2346 x 1568 pixels — 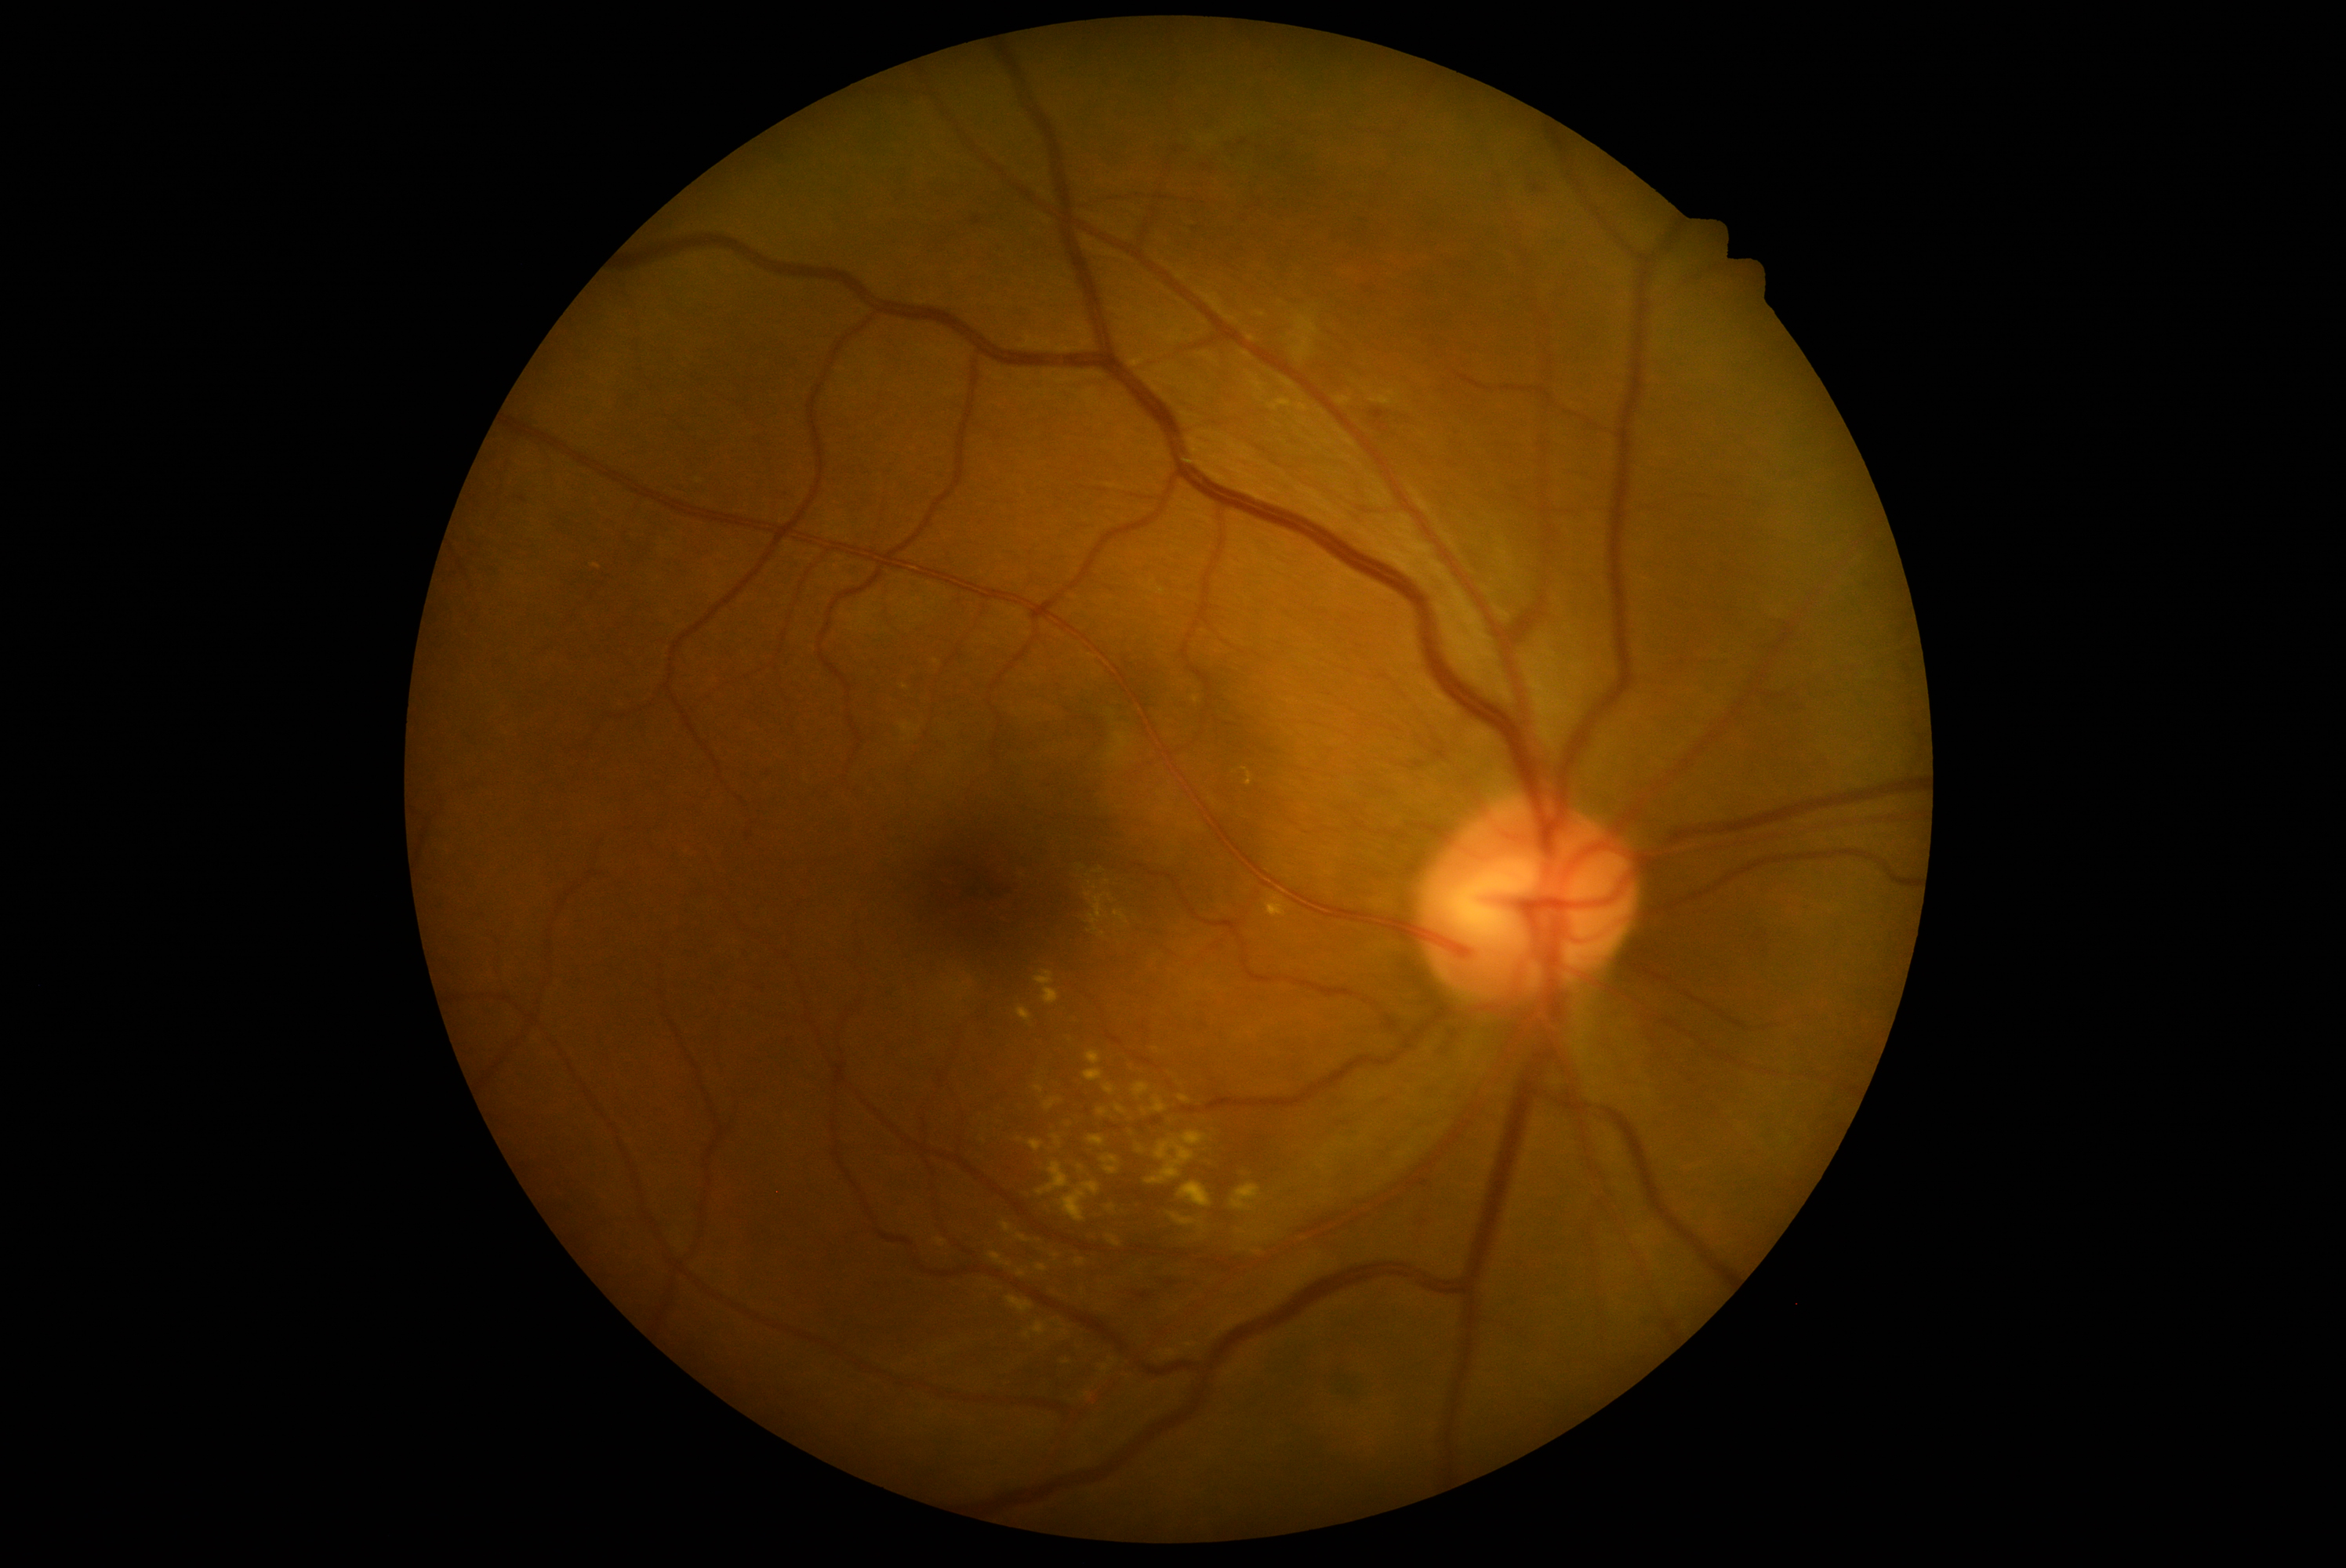 <lesions partial="true">
  <dr_grade>2</dr_grade>
  <ex partial="true">l=1130, t=1128, r=1136, b=1139; l=1084, t=1070, r=1103, b=1083; l=1017, t=1235, r=1030, b=1244; l=1033, t=1323, r=1047, b=1337; l=1028, t=1141, r=1044, b=1152; l=1034, t=971, r=1059, b=1006; l=1078, t=1166, r=1084, b=1174; l=1036, t=1163, r=1070, b=1197; l=592, t=565, r=601, b=570; l=990, t=1252, r=1012, b=1268; l=1166, t=1351, r=1178, b=1359; l=1053, t=1136, r=1061, b=1147</ex>
  <ex_small_centers>pt(1113, 1360); pt(1156, 1050); pt(905, 688); pt(1102, 934); pt(1161, 1355)</ex_small_centers>
</lesions>